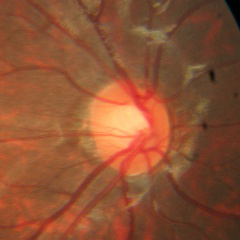
Glaucoma stage = no glaucomatous optic neuropathy.